Centered on the macula.
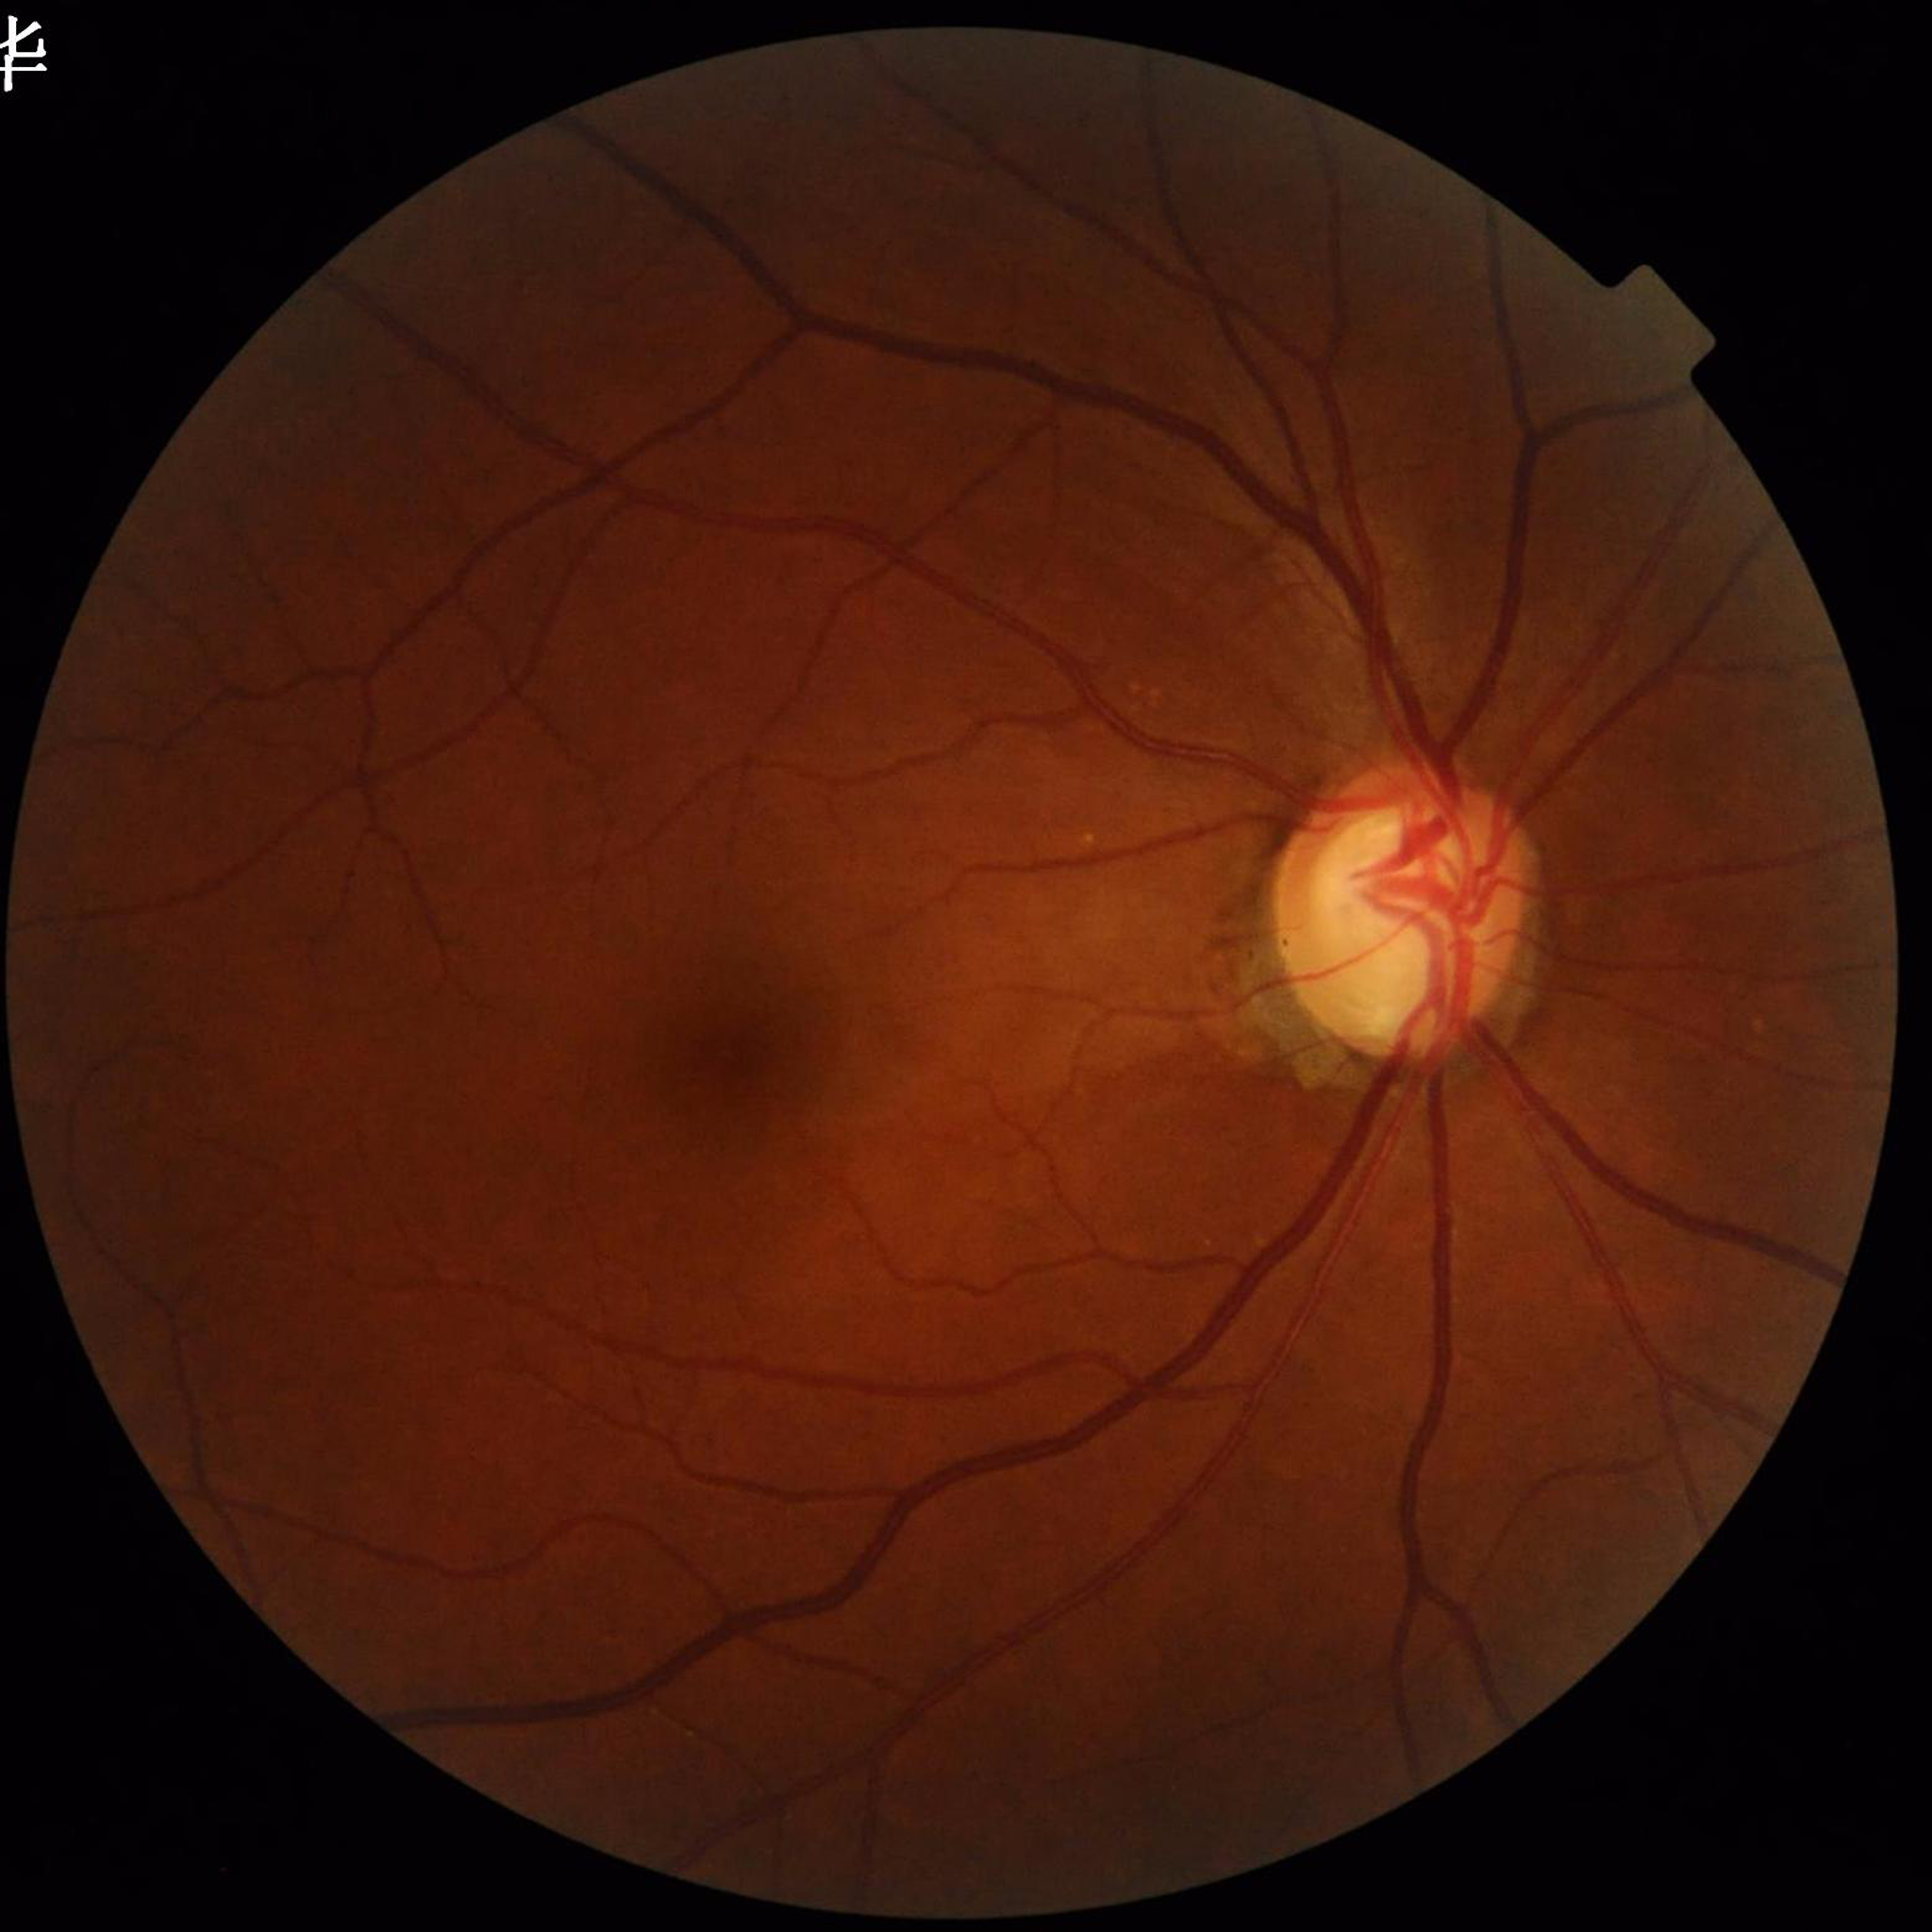
Impression: glaucoma.